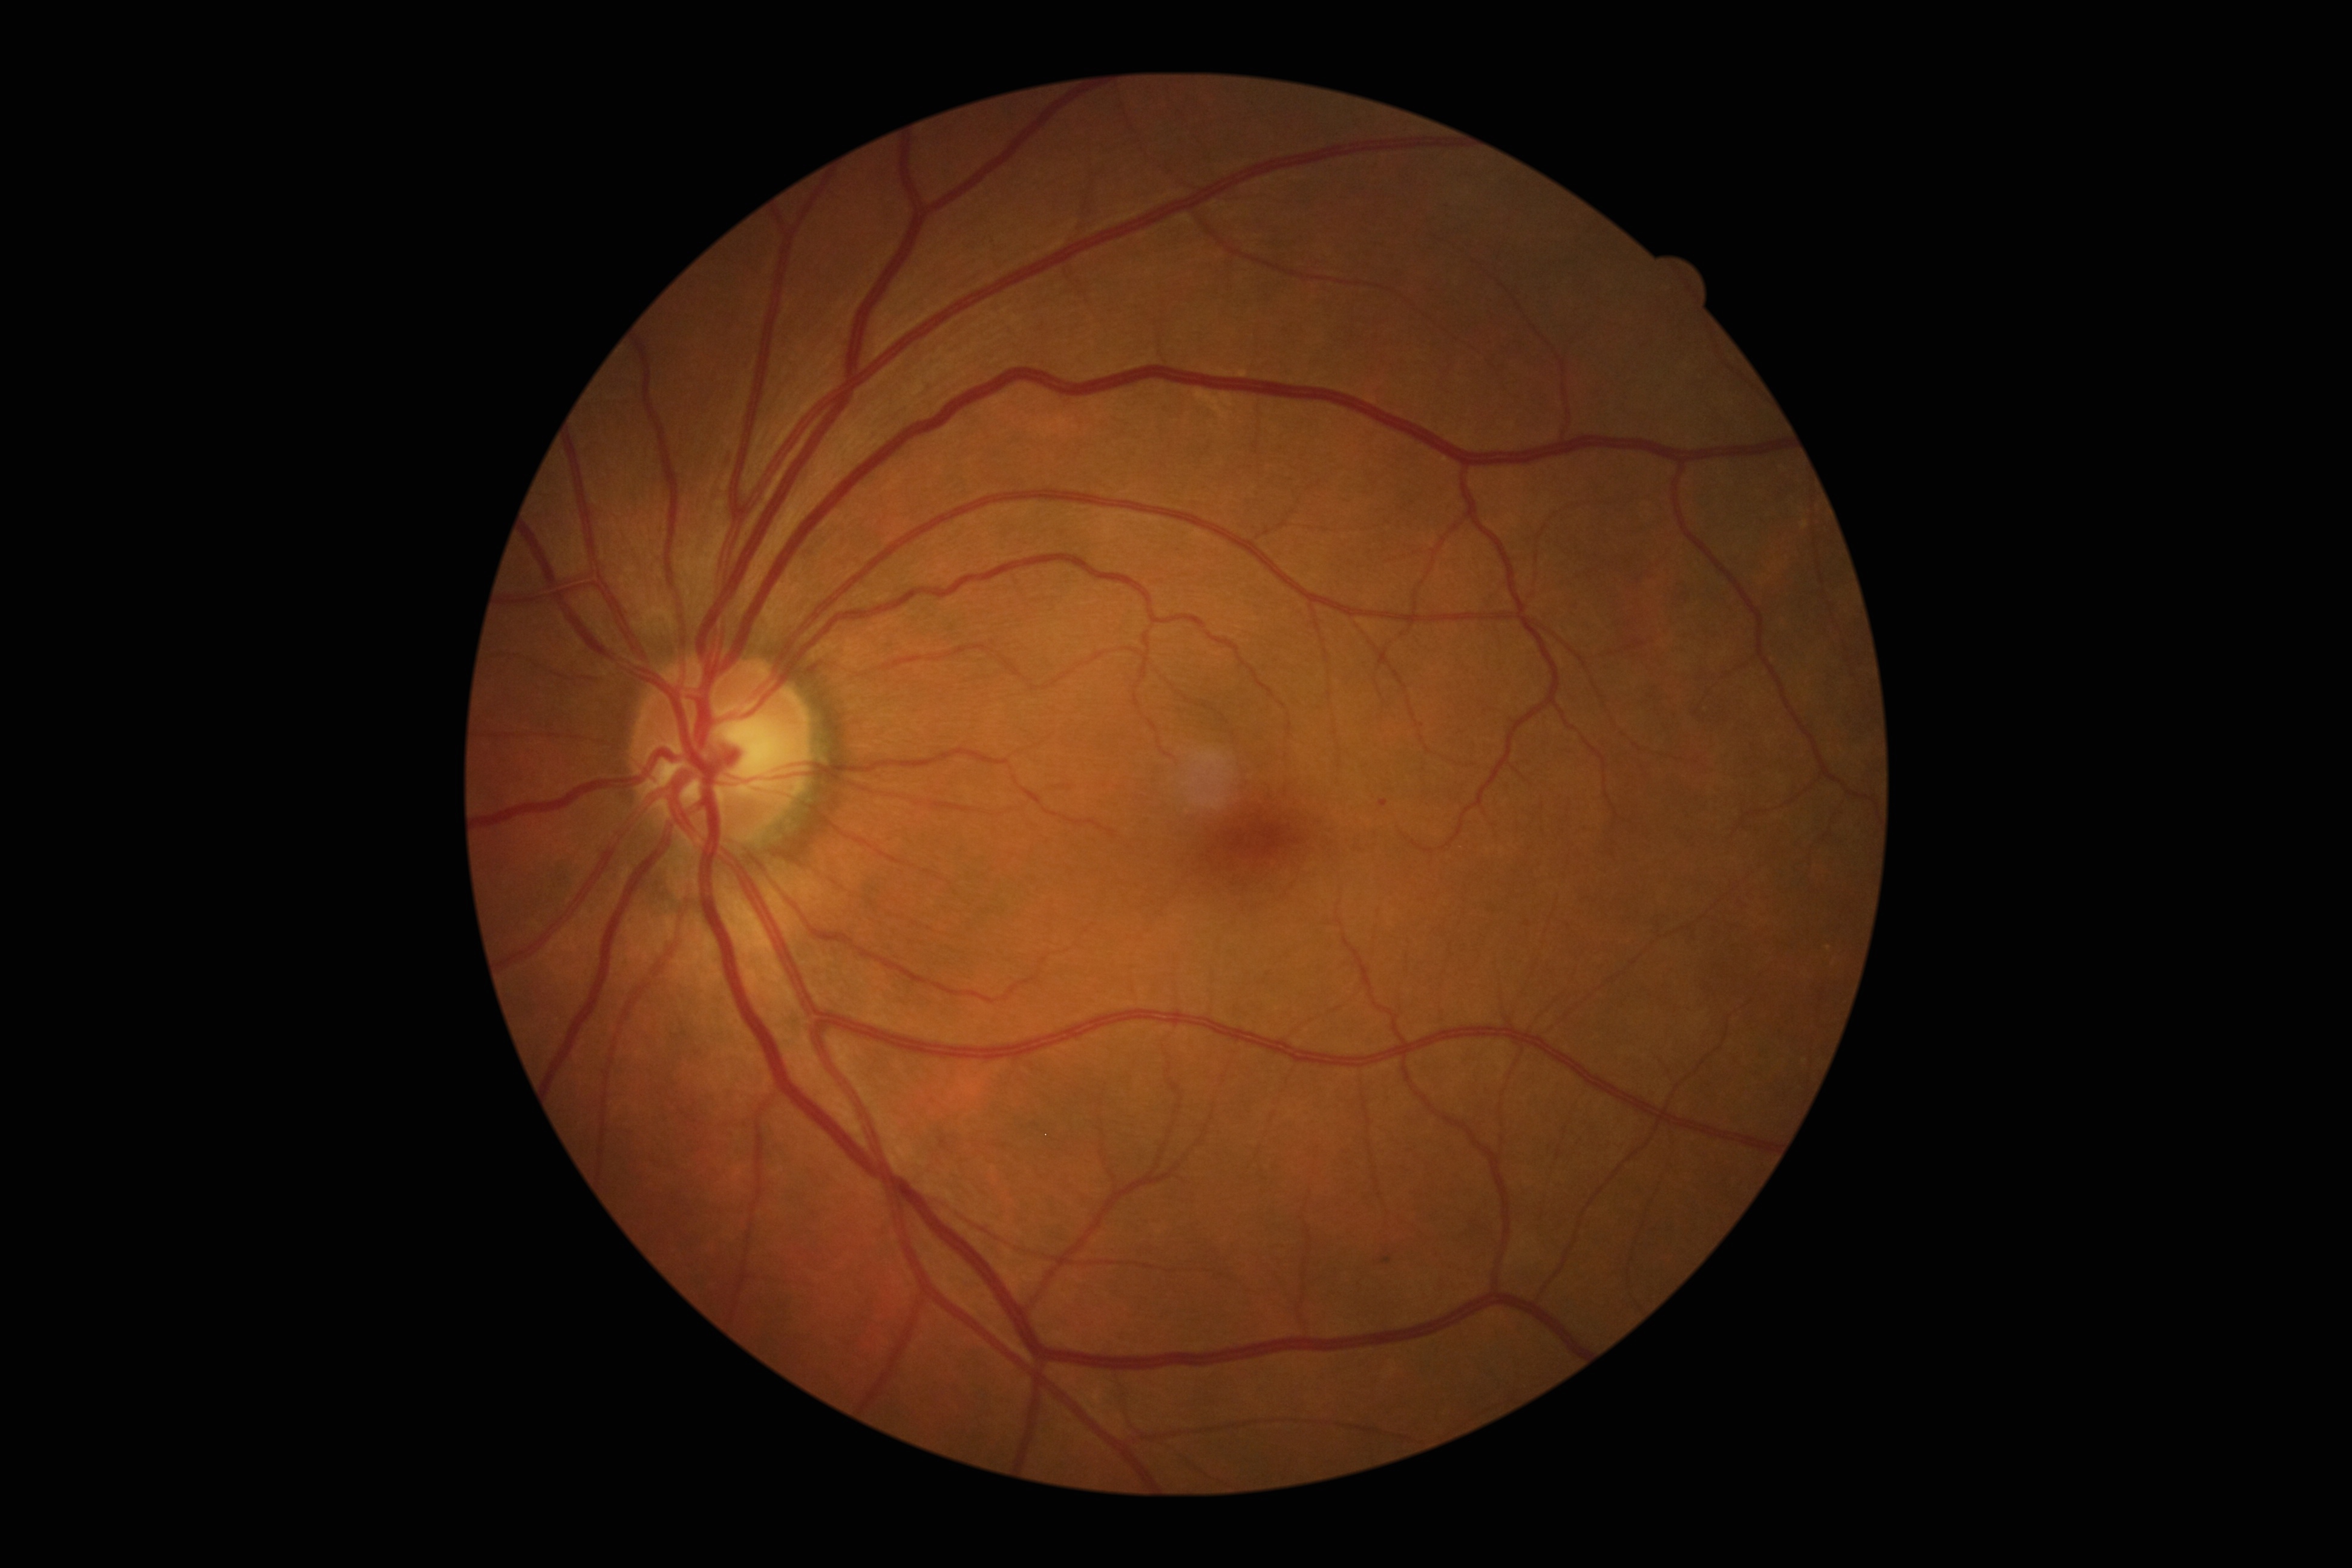
Diabetic retinopathy (DR): grade 1. Disease class: non-proliferative diabetic retinopathy.